Retinal fundus photograph — 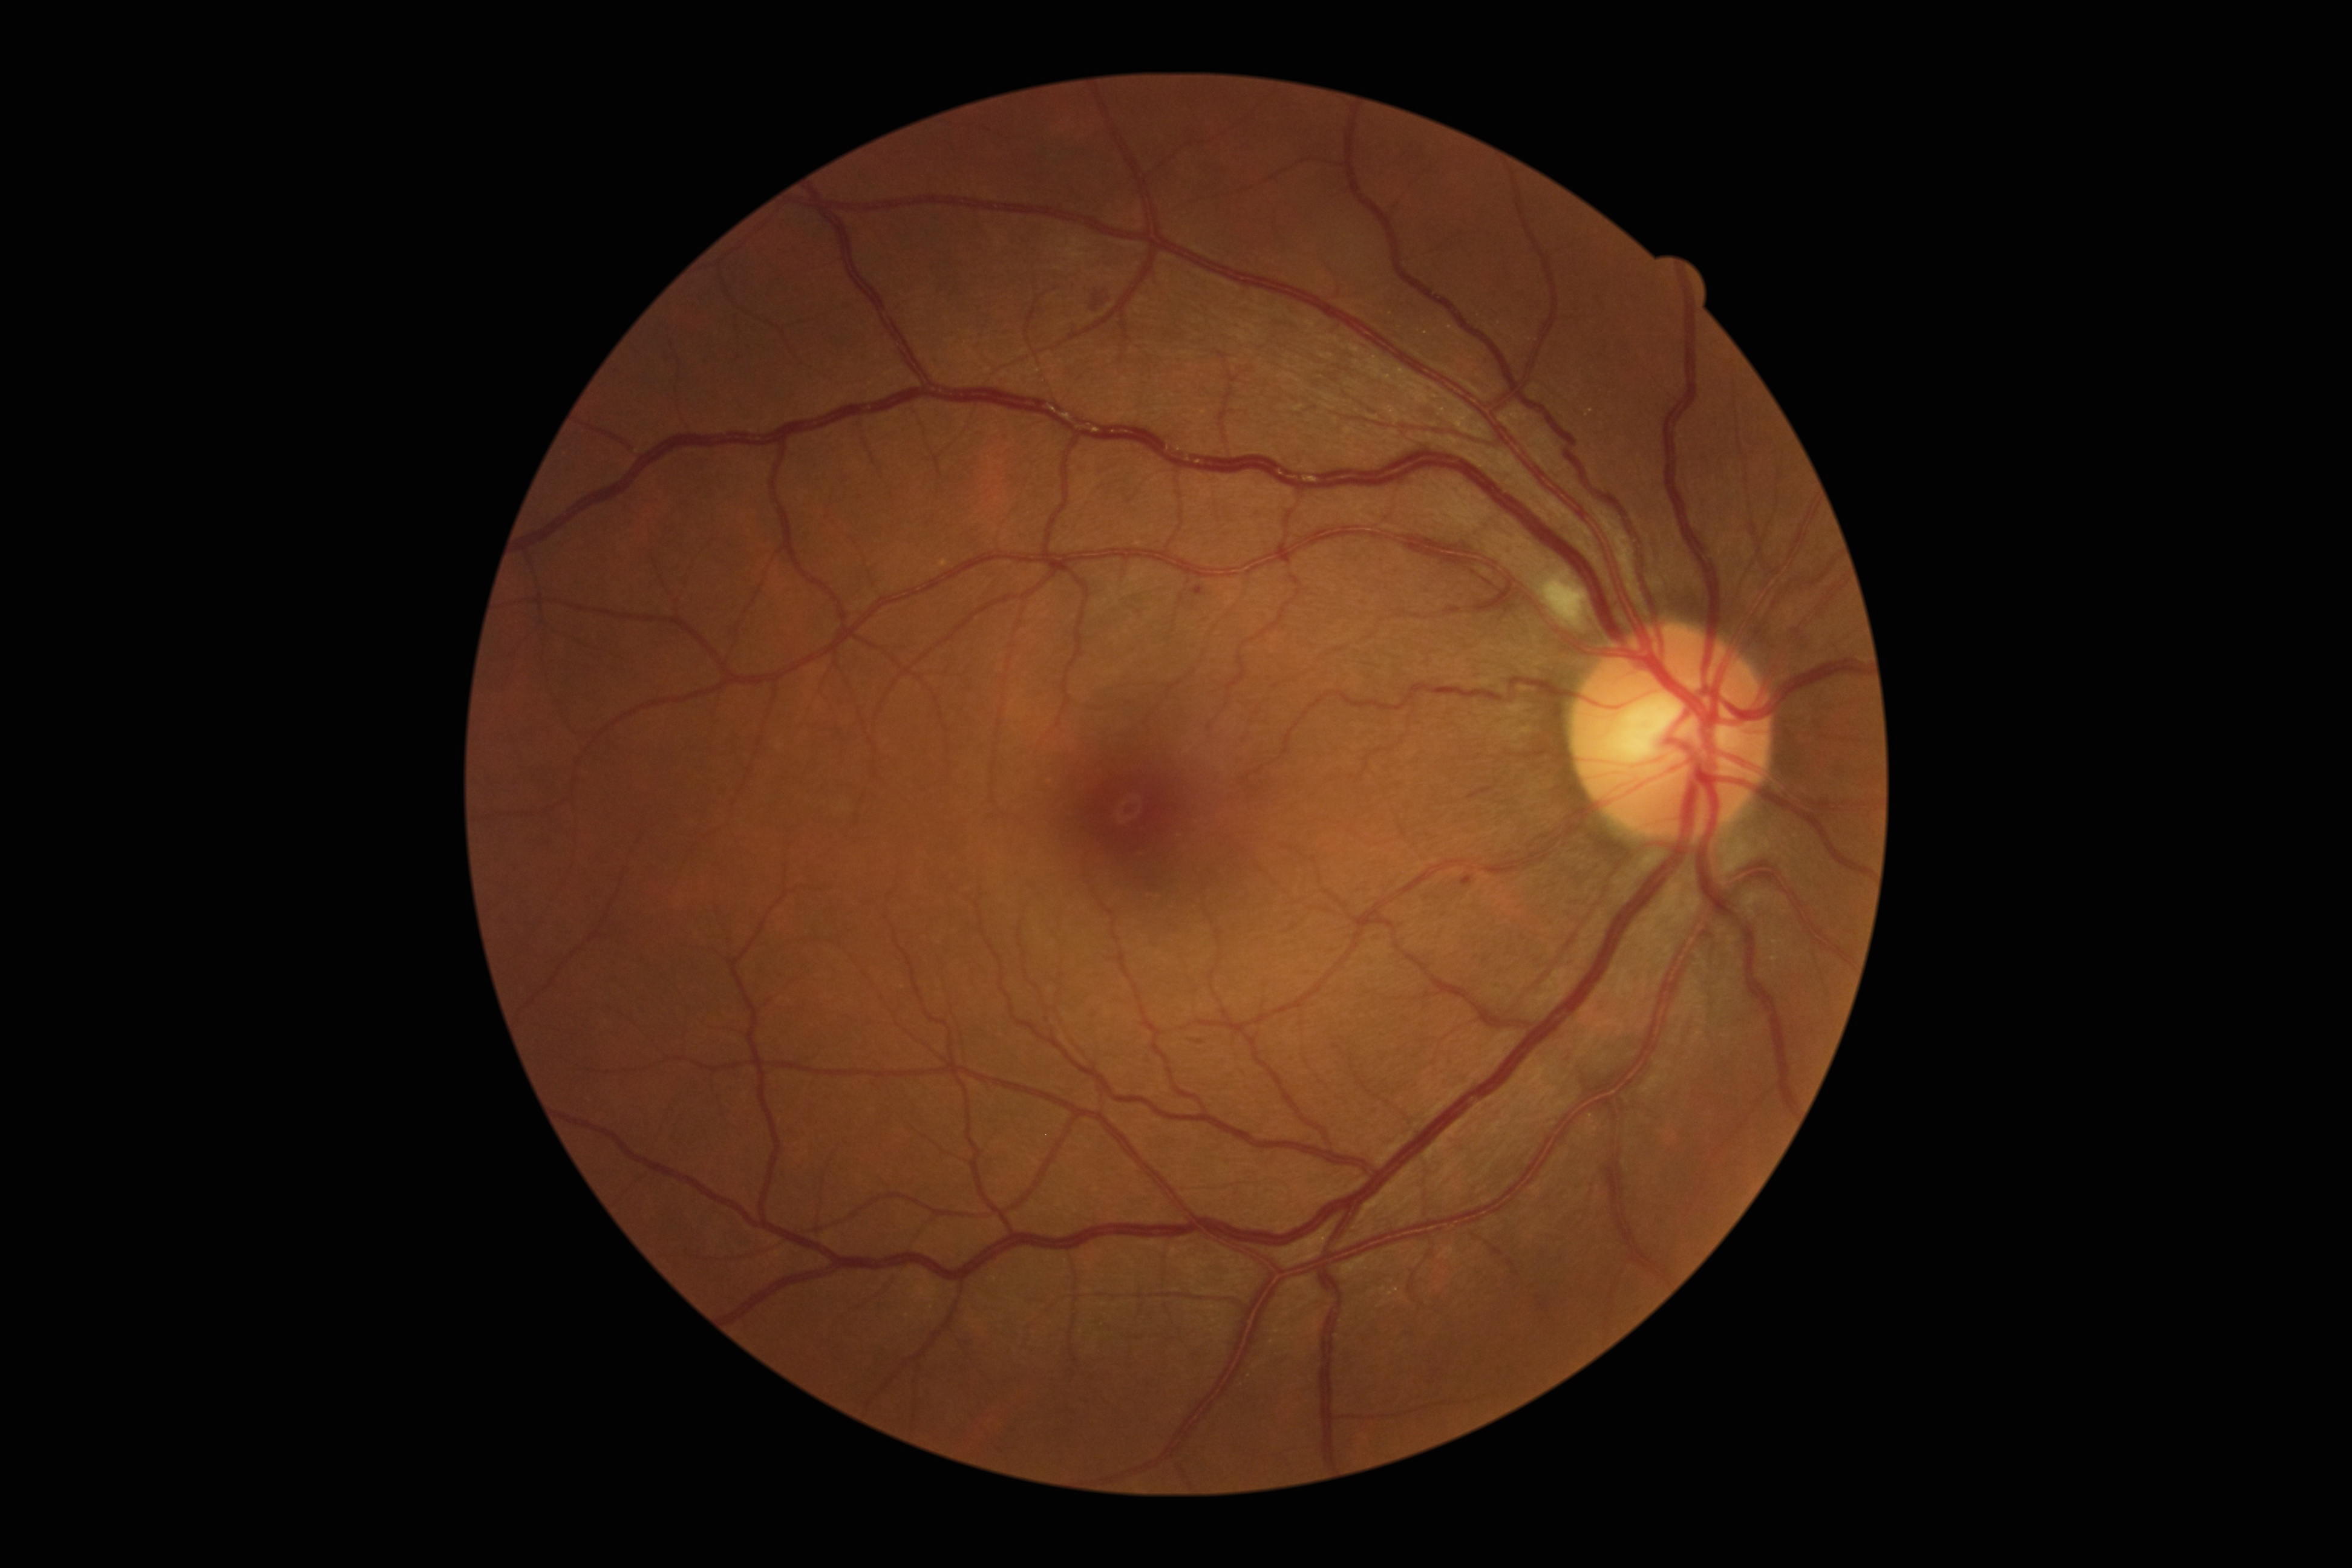 <lesions partial="true">
  <dr_grade>2</dr_grade>
  <ex />
  <he partial="true">region(1082, 296, 1110, 312) | region(1192, 1039, 1203, 1045)</he>
  <se>region(1547, 575, 1586, 626)</se>
  <ma>region(1461, 875, 1474, 886) | region(1192, 585, 1206, 595)</ma>
</lesions>